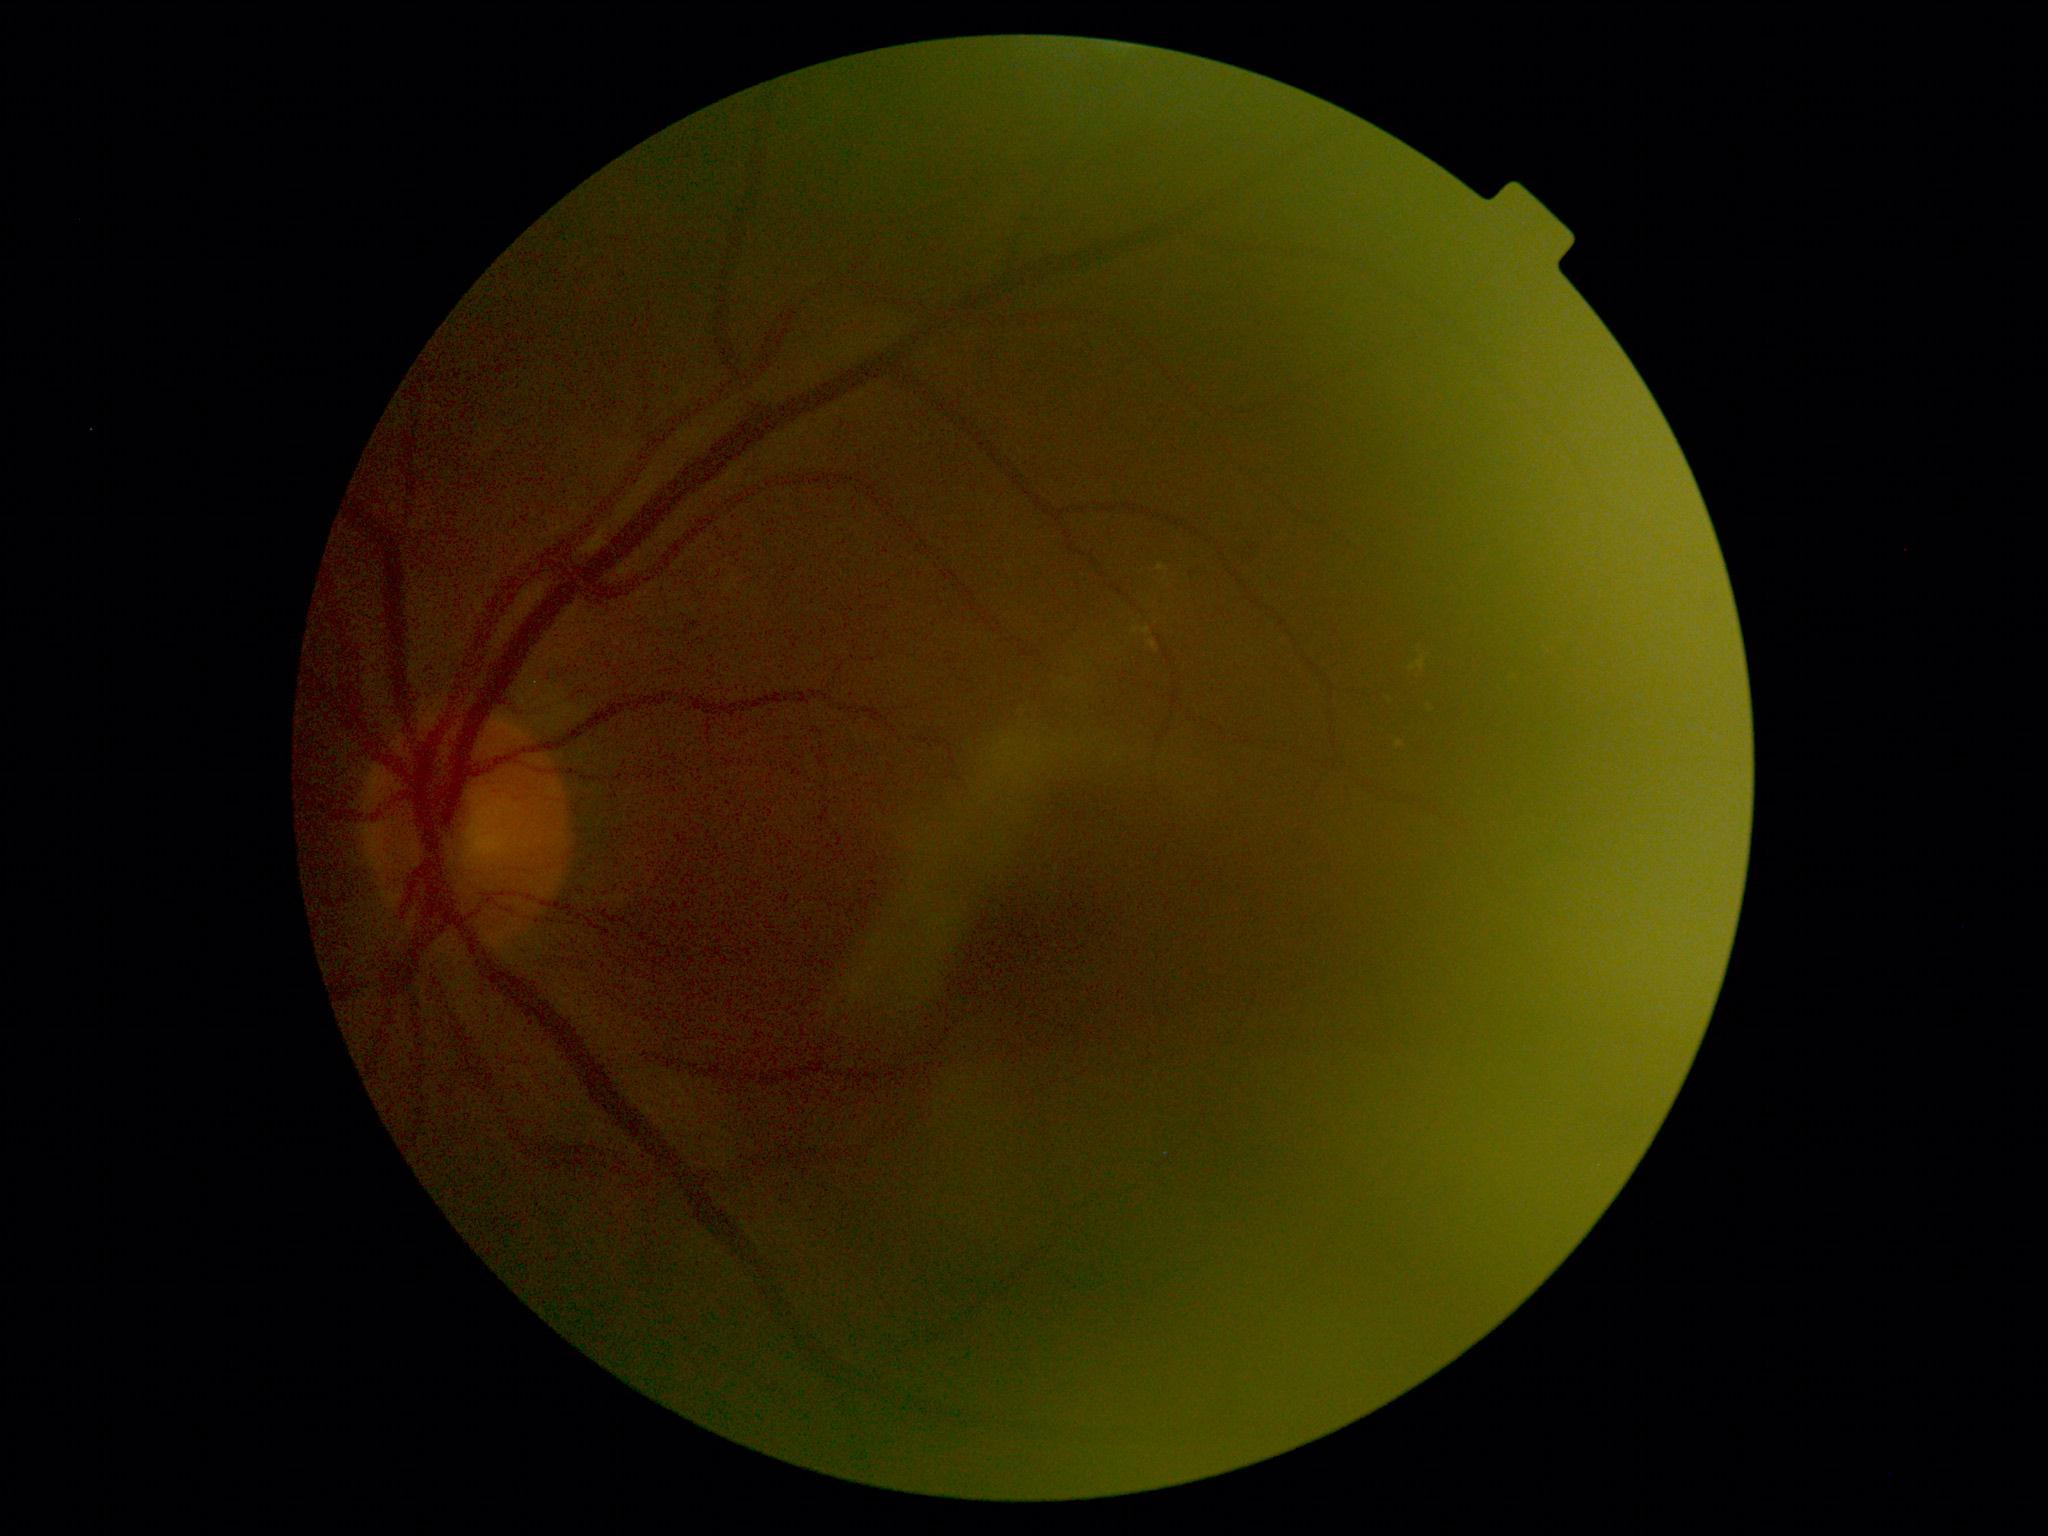 DR stage is 2.